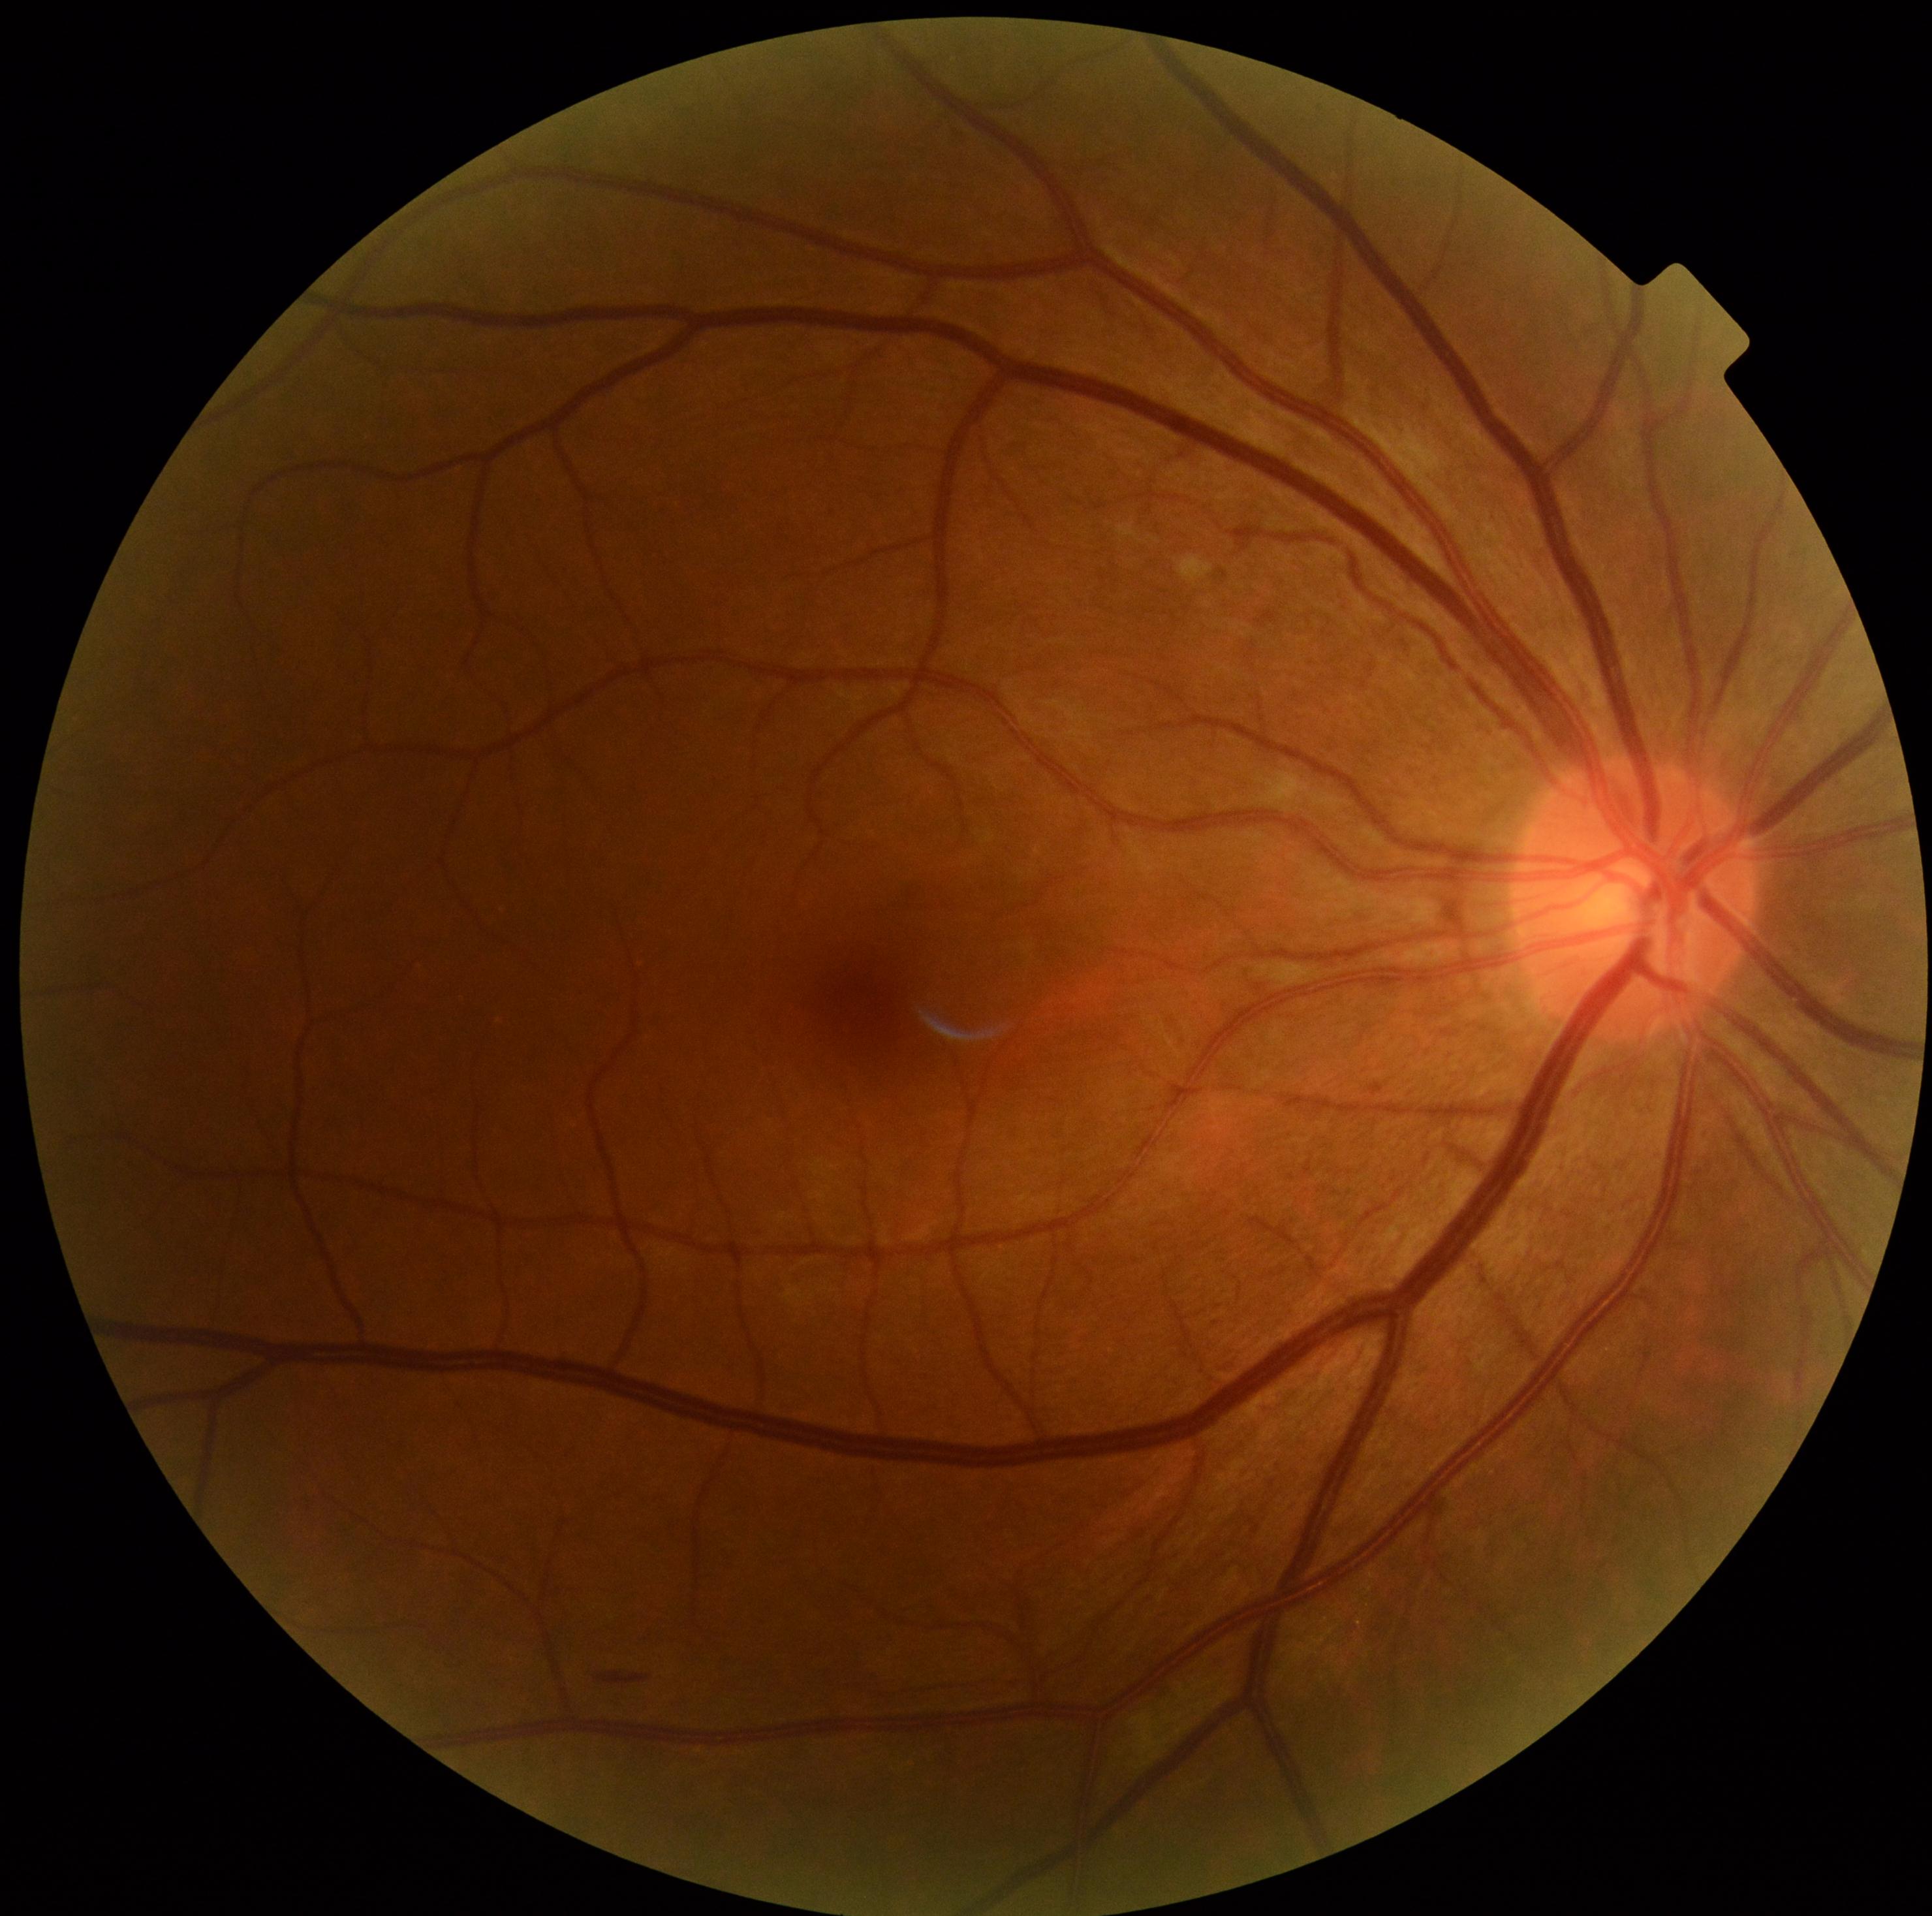

DR stage: 2/4. The retinopathy is classified as non-proliferative diabetic retinopathy.